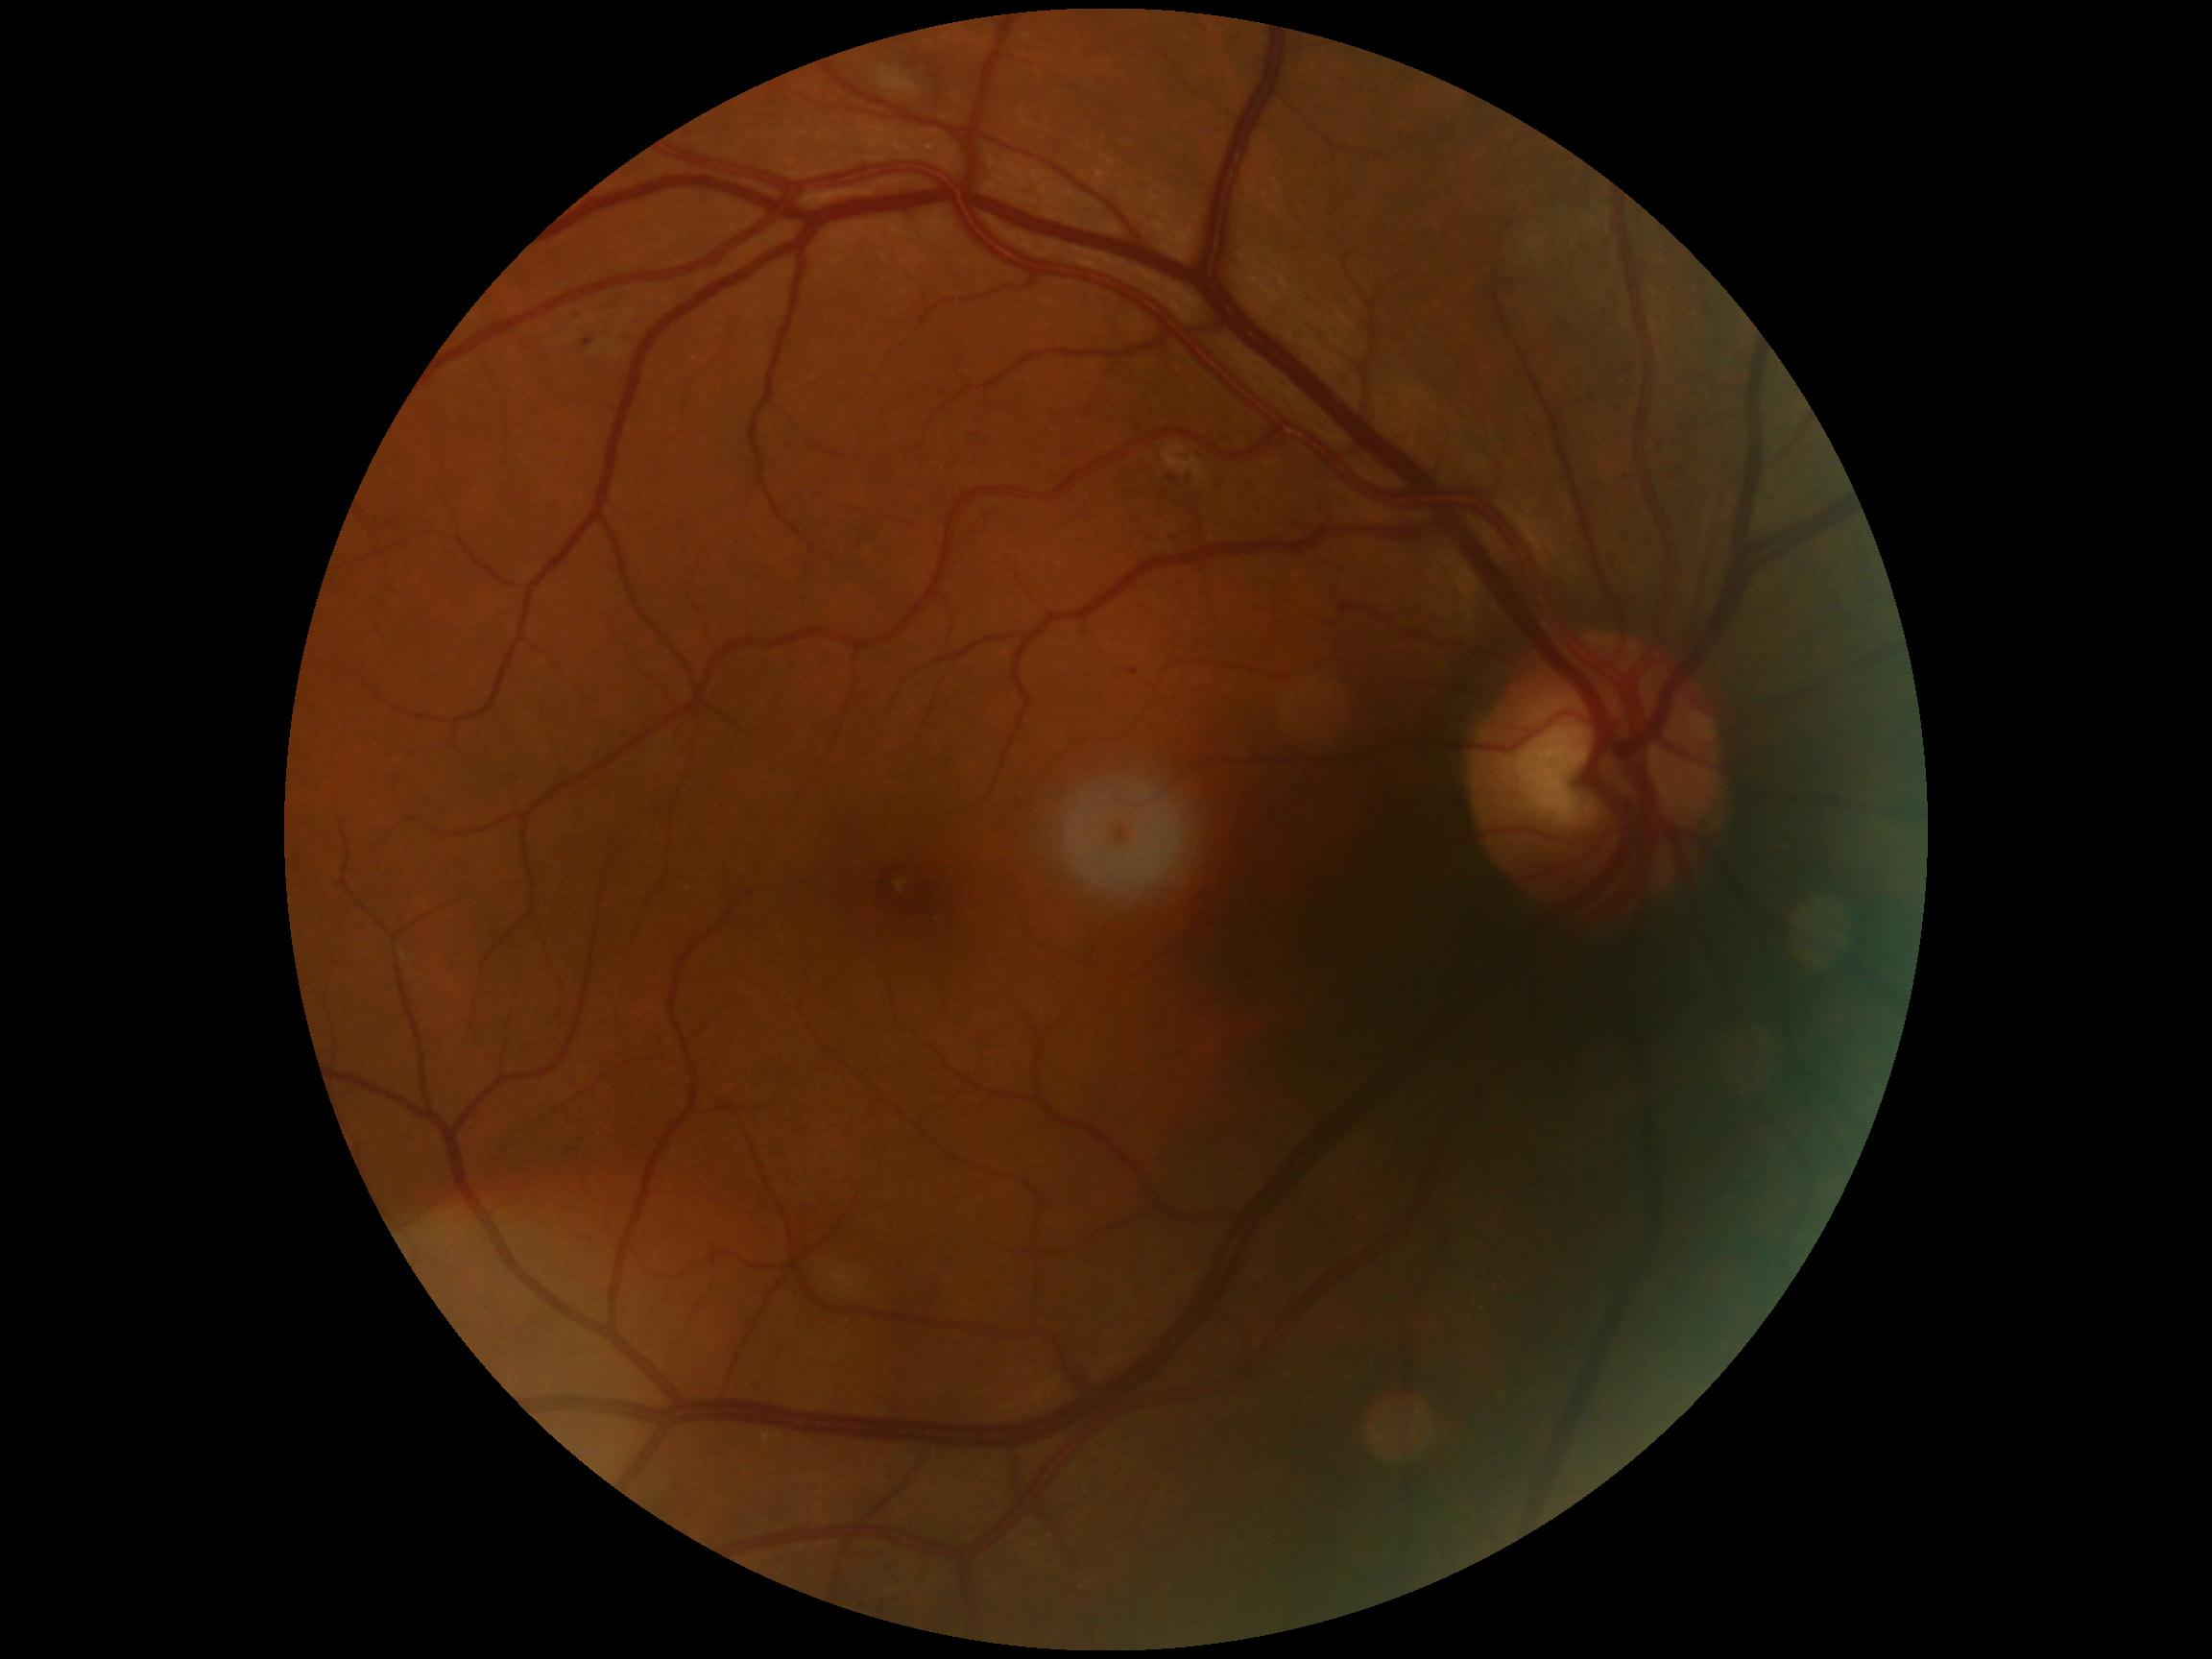
  dr_grade: moderate NPDR (2)